640x480px. Pediatric retinal photograph (wide-field)
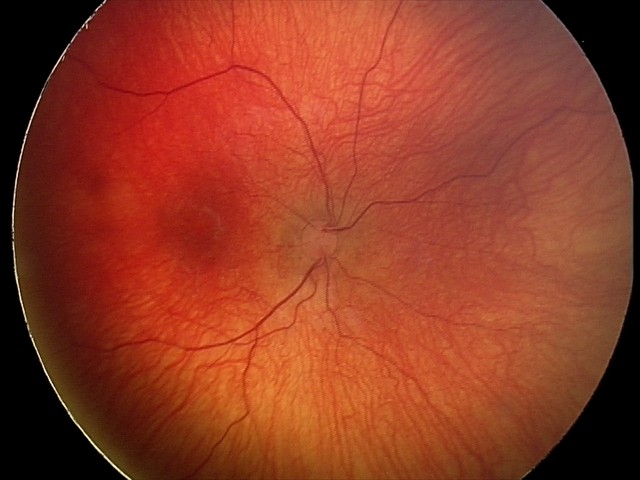 Diagnosis = status post retinopathy of prematurity (ROP).